Posterior pole view, fundus photo, 50° field of view.
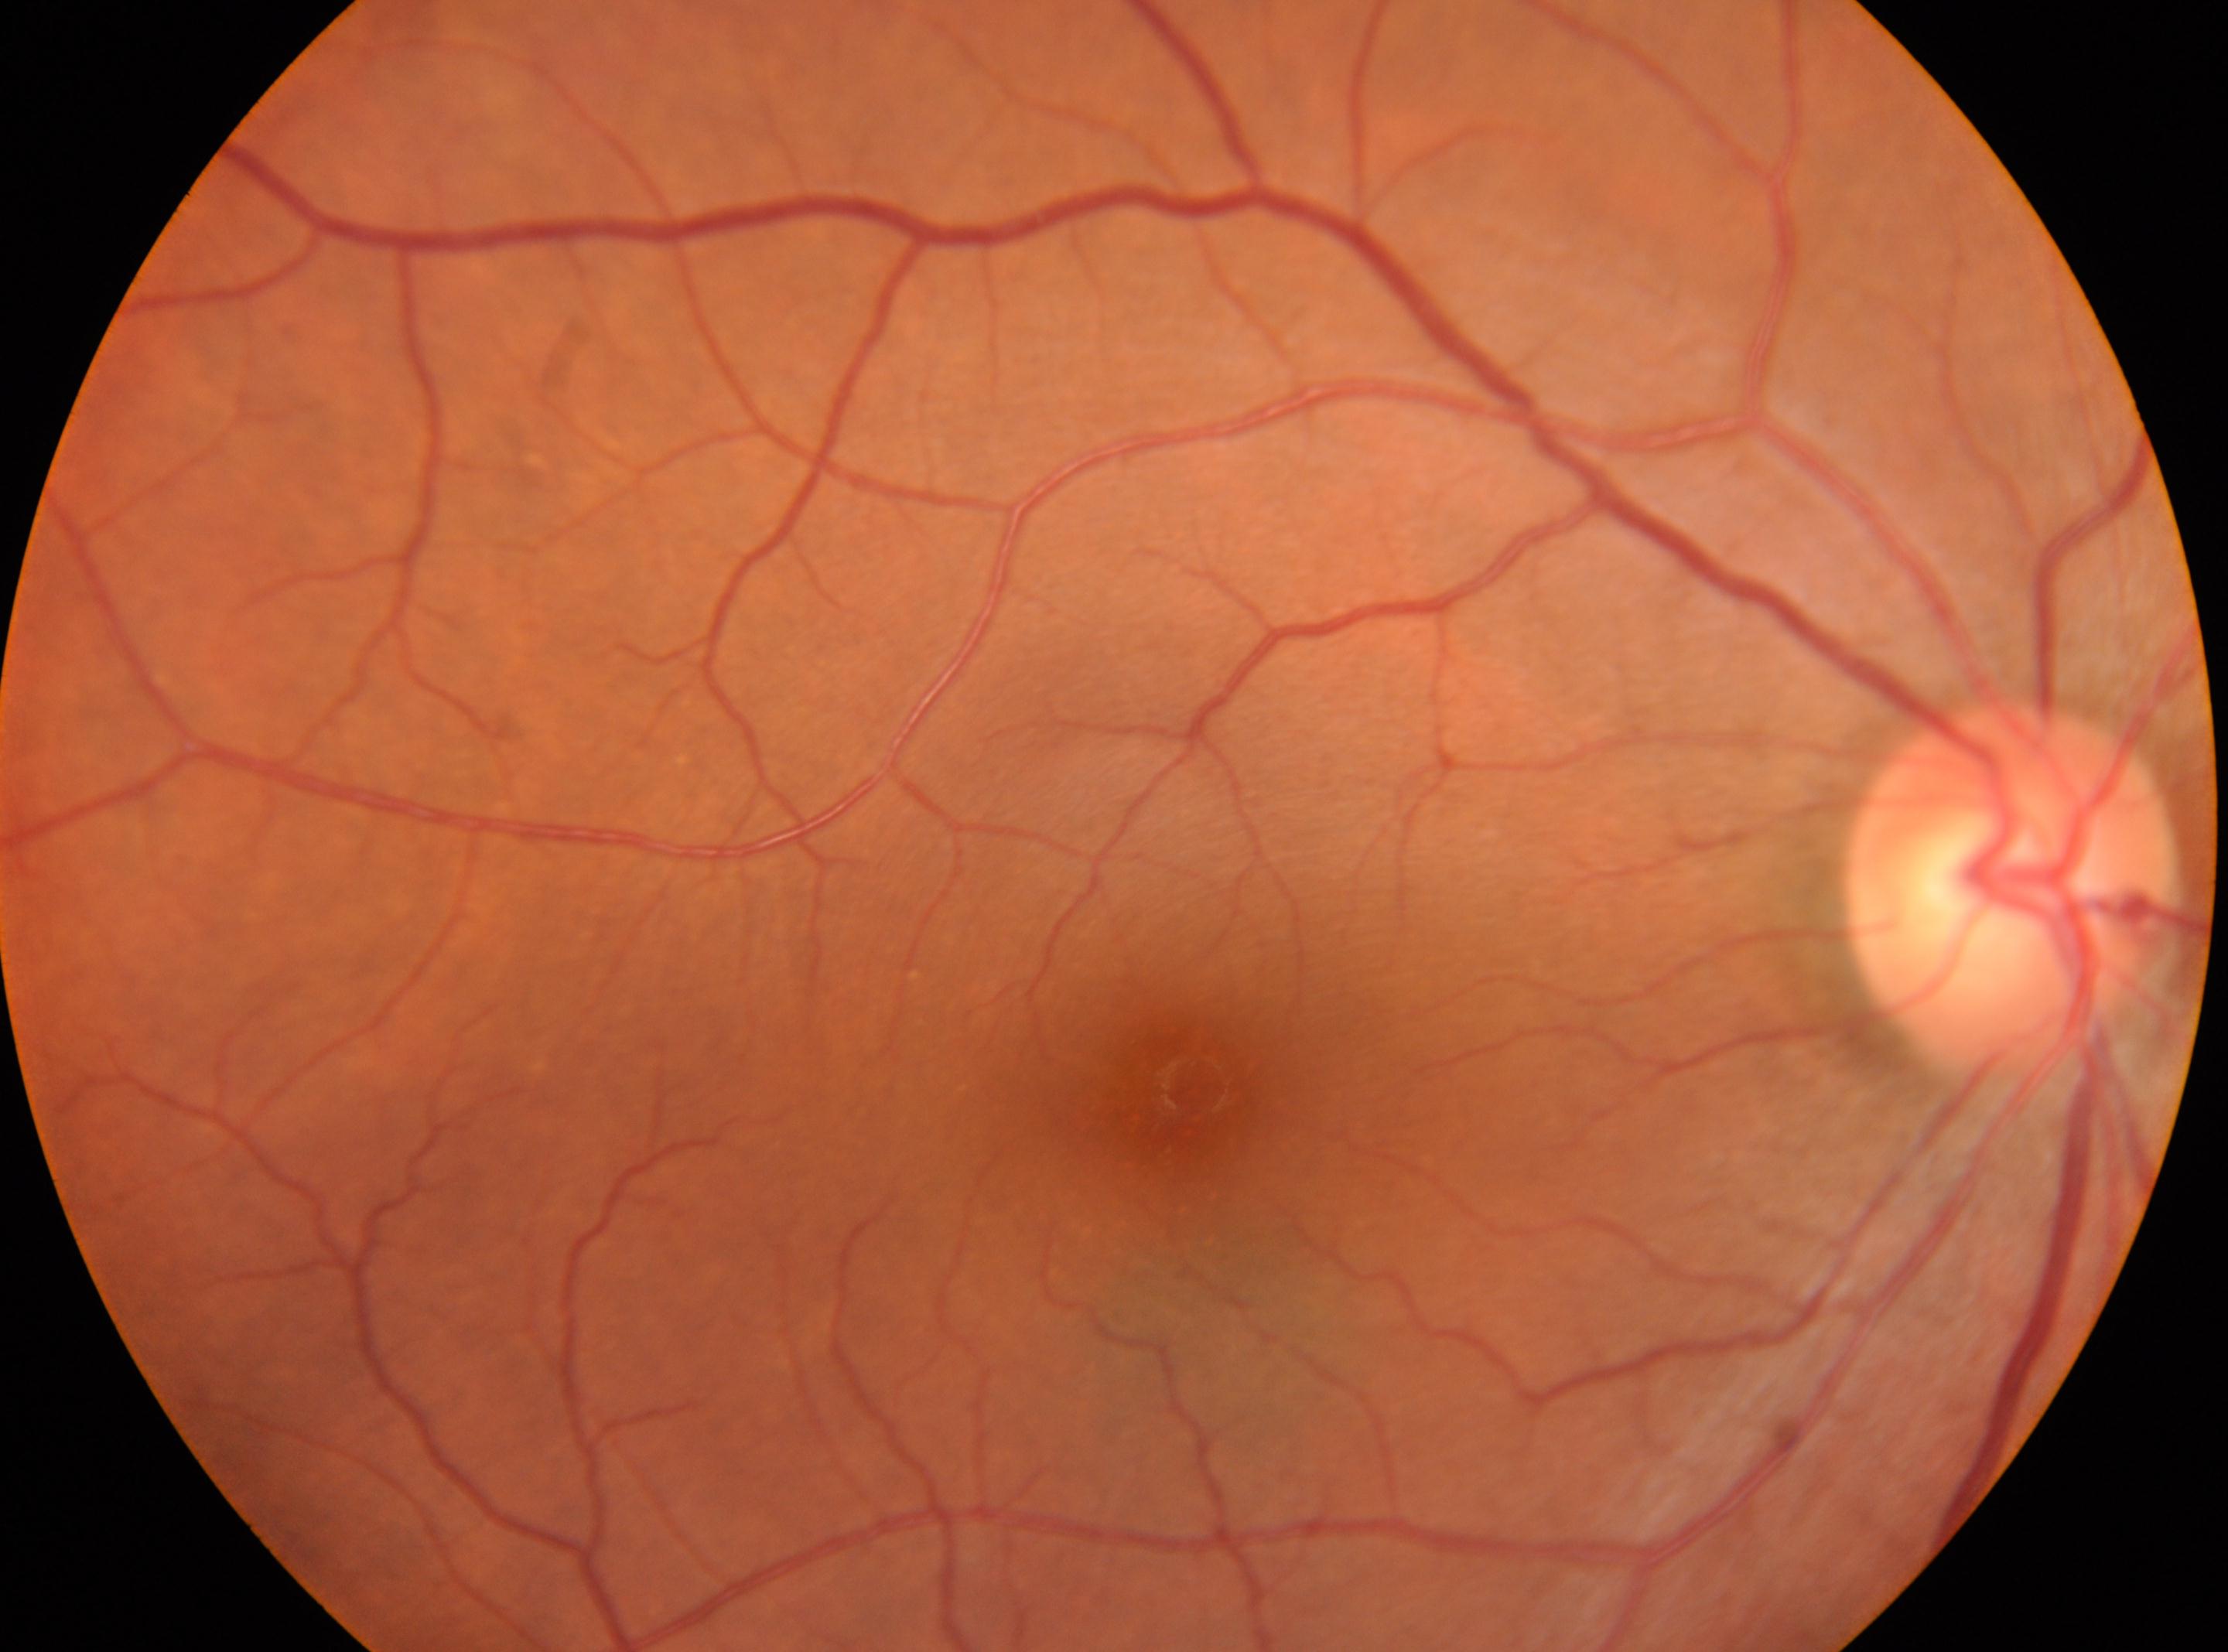

* fovea: [1179, 1094]
* optic disk: [2011, 886]
* diabetic retinopathy grade: 0
* DR impression: No apparent diabetic retinopathy
* eye: OD